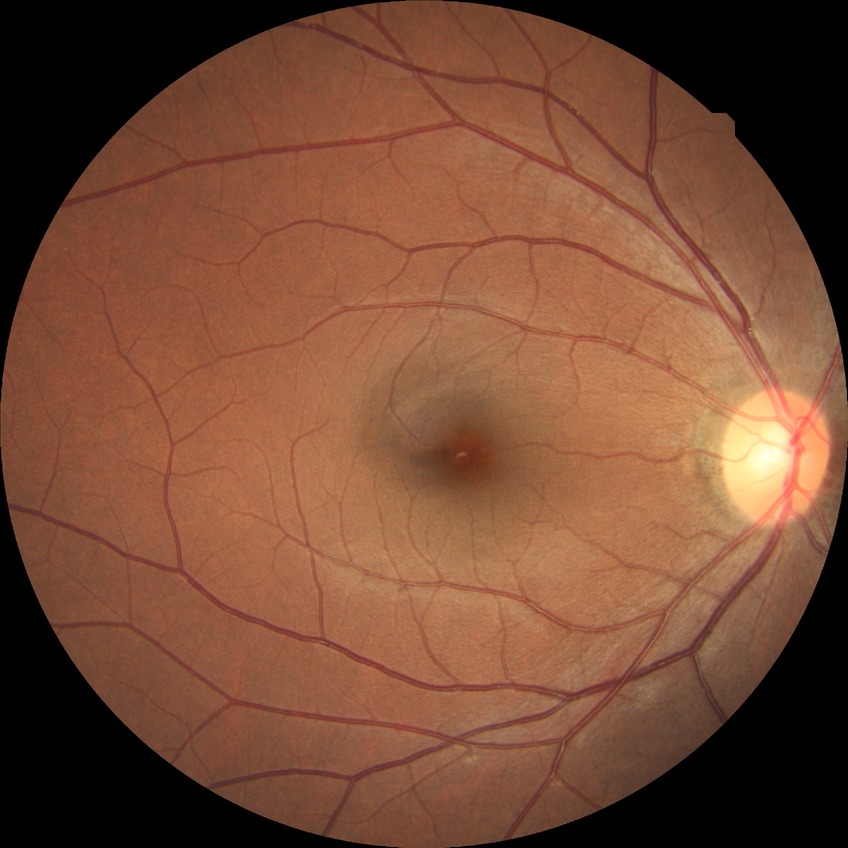
DR stage: NDR.